Color fundus photograph
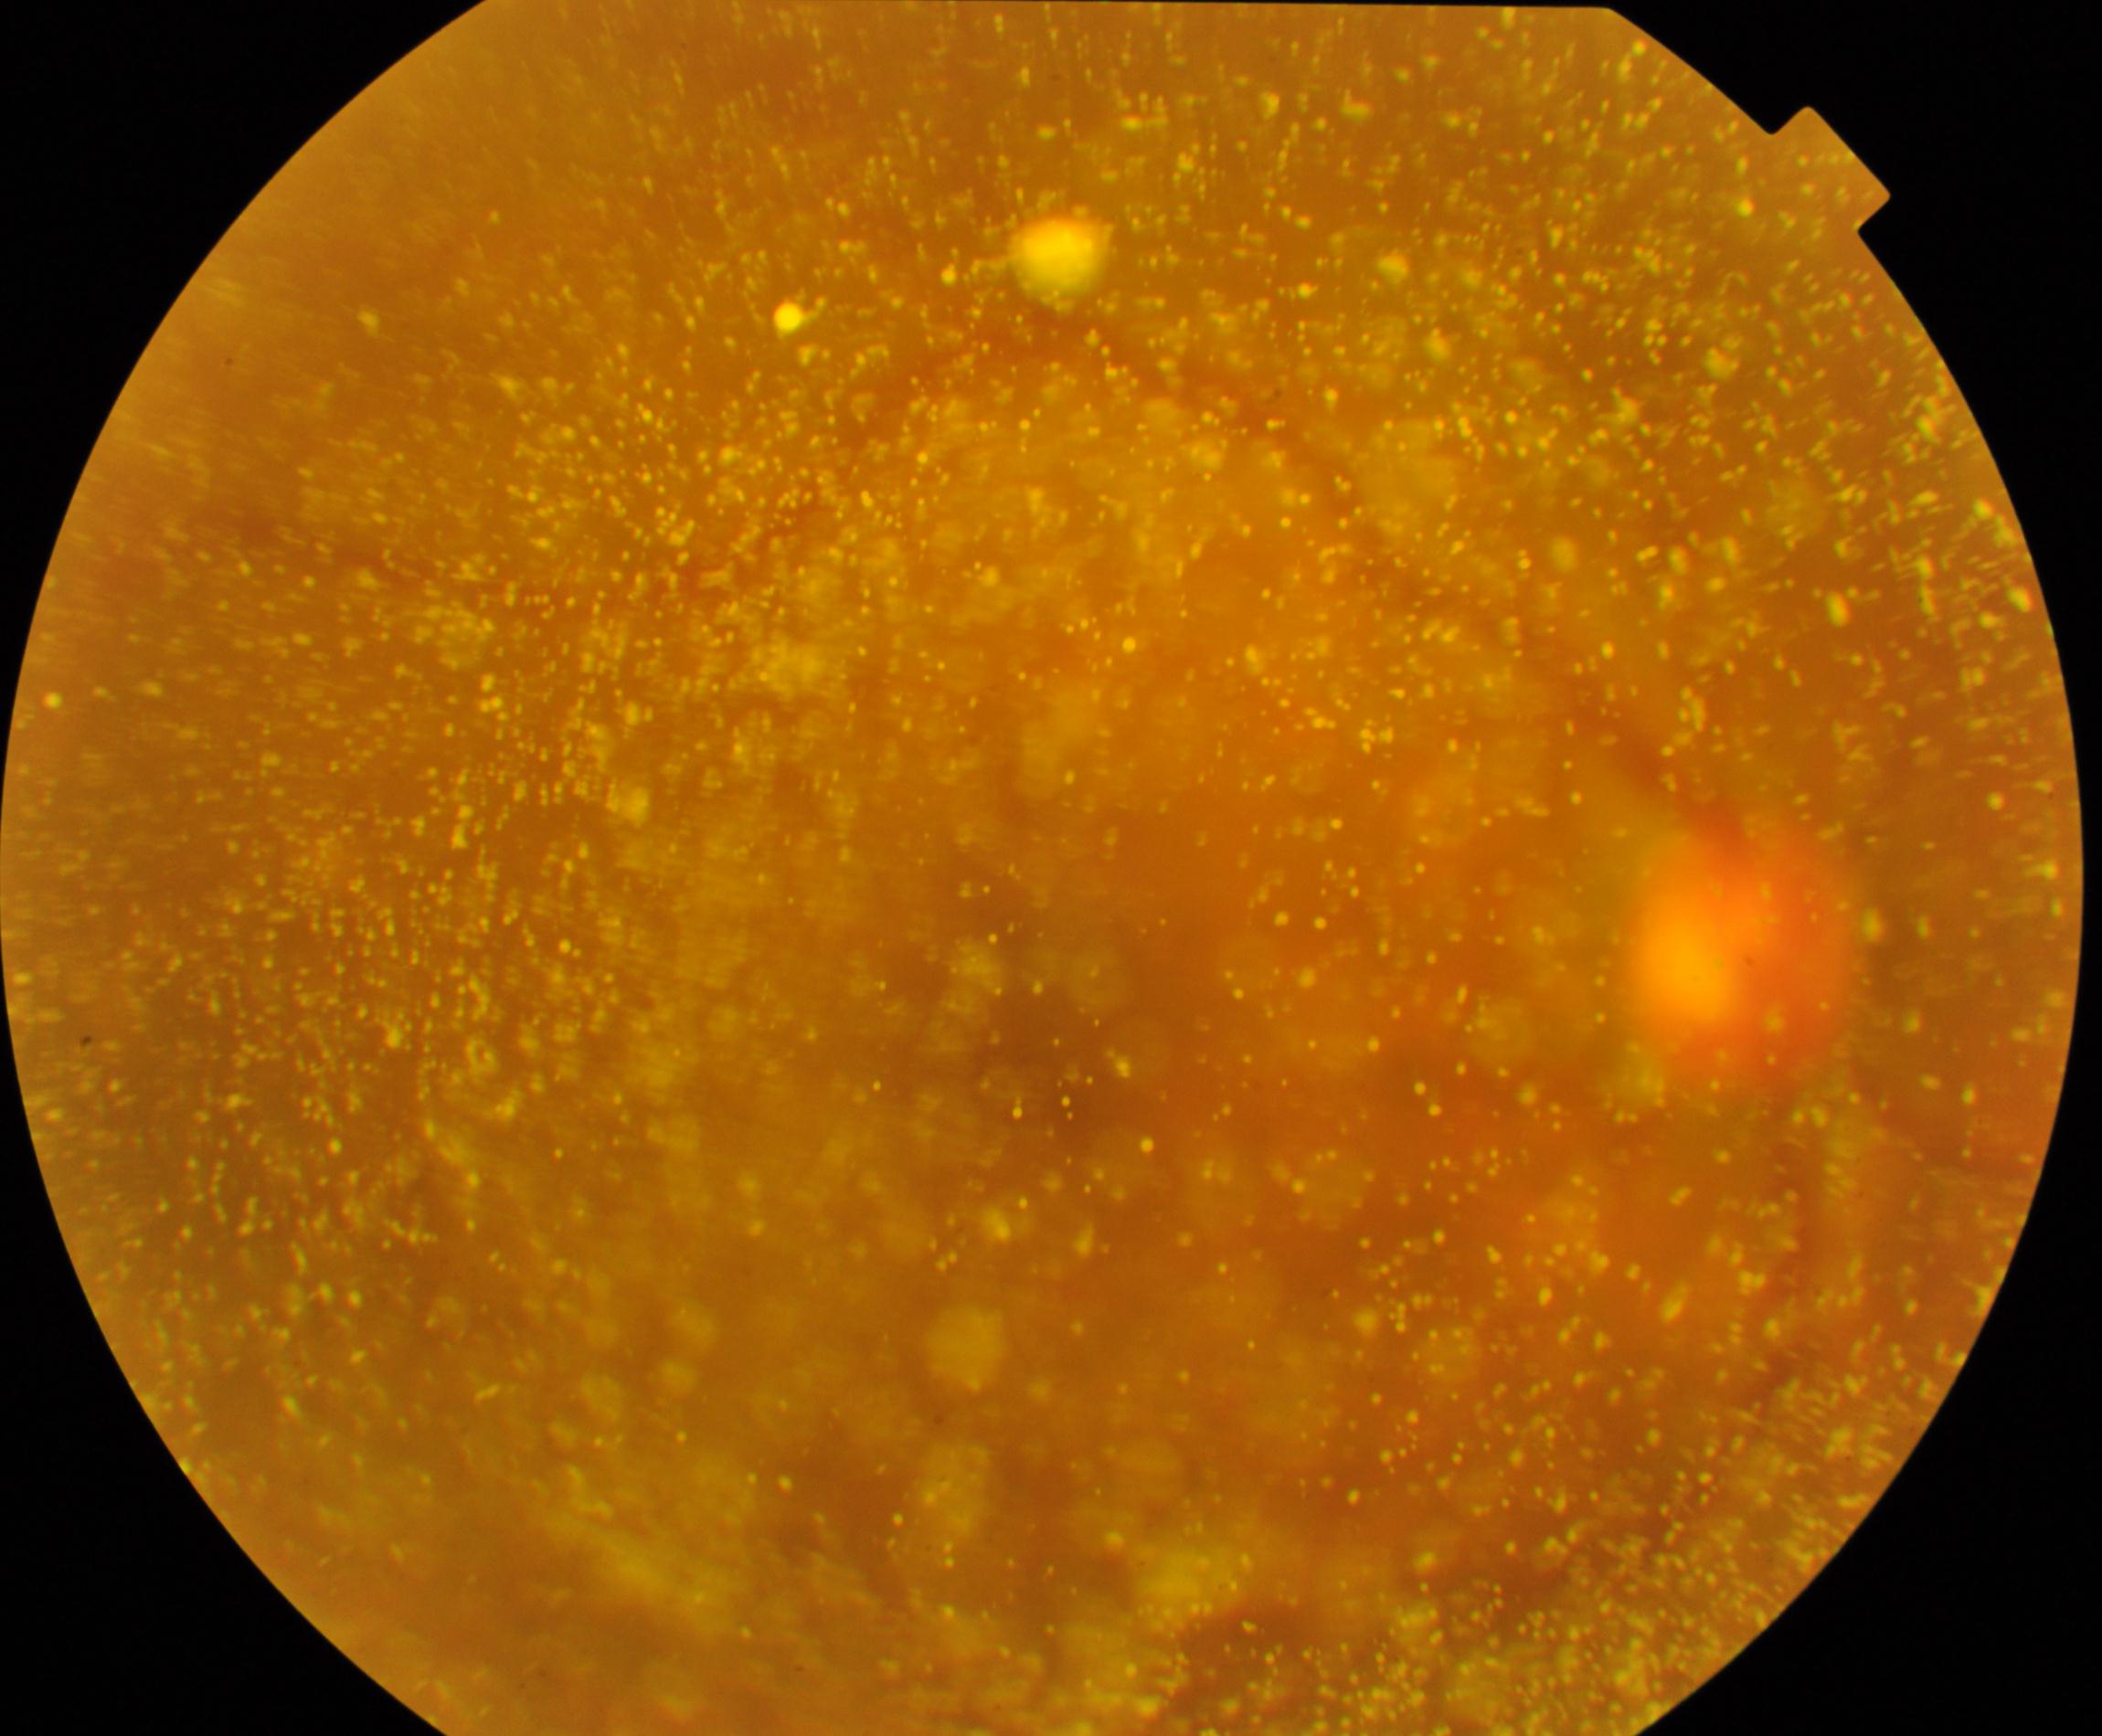
The image shows vitreous particles.